Wide-field fundus photograph of an infant — 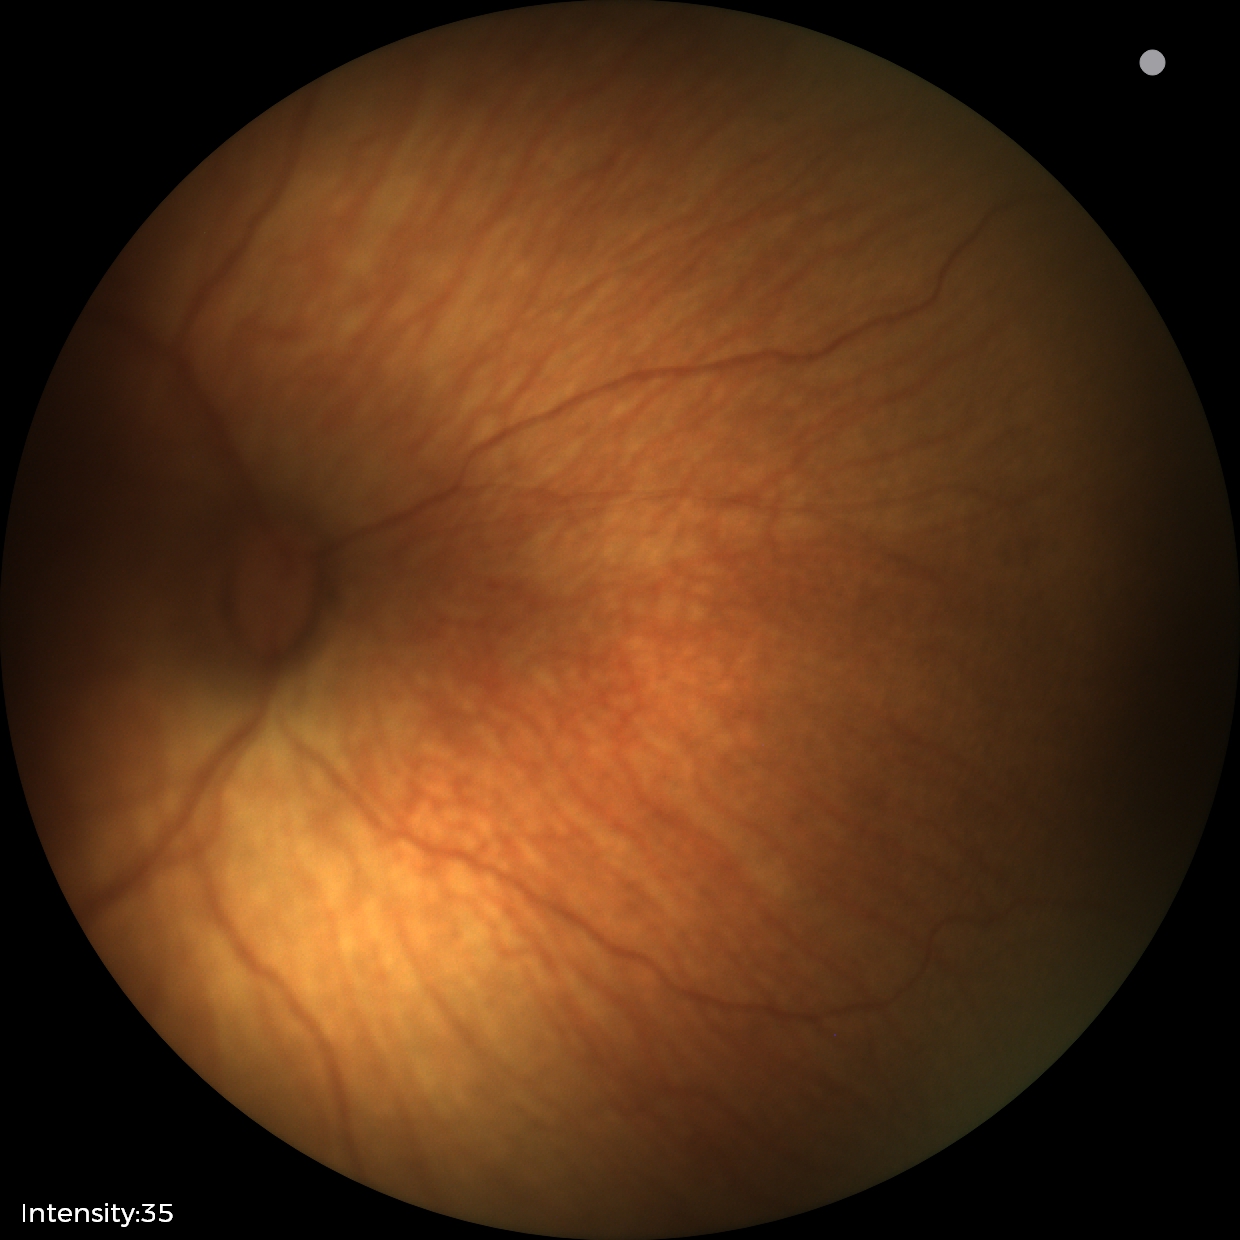 Without plus disease. From an examination with diagnosis of status post retinopathy of prematurity.